Non-mydriatic fundus camera
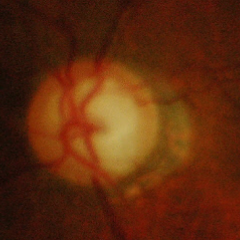
Early-stage glaucoma.